RetCam wide-field infant fundus image — 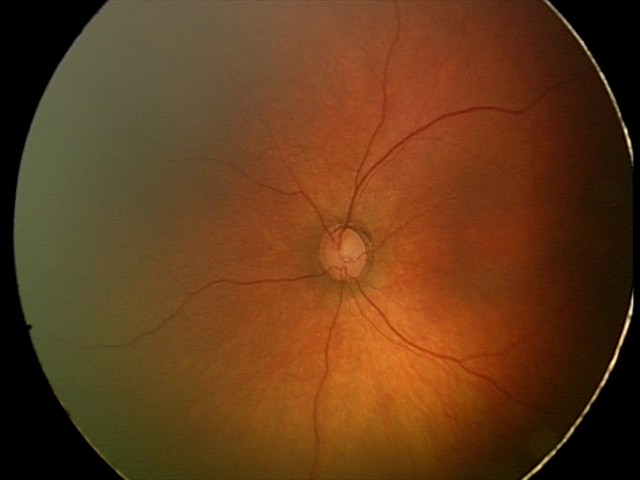
No retinal pathology identified on screening.